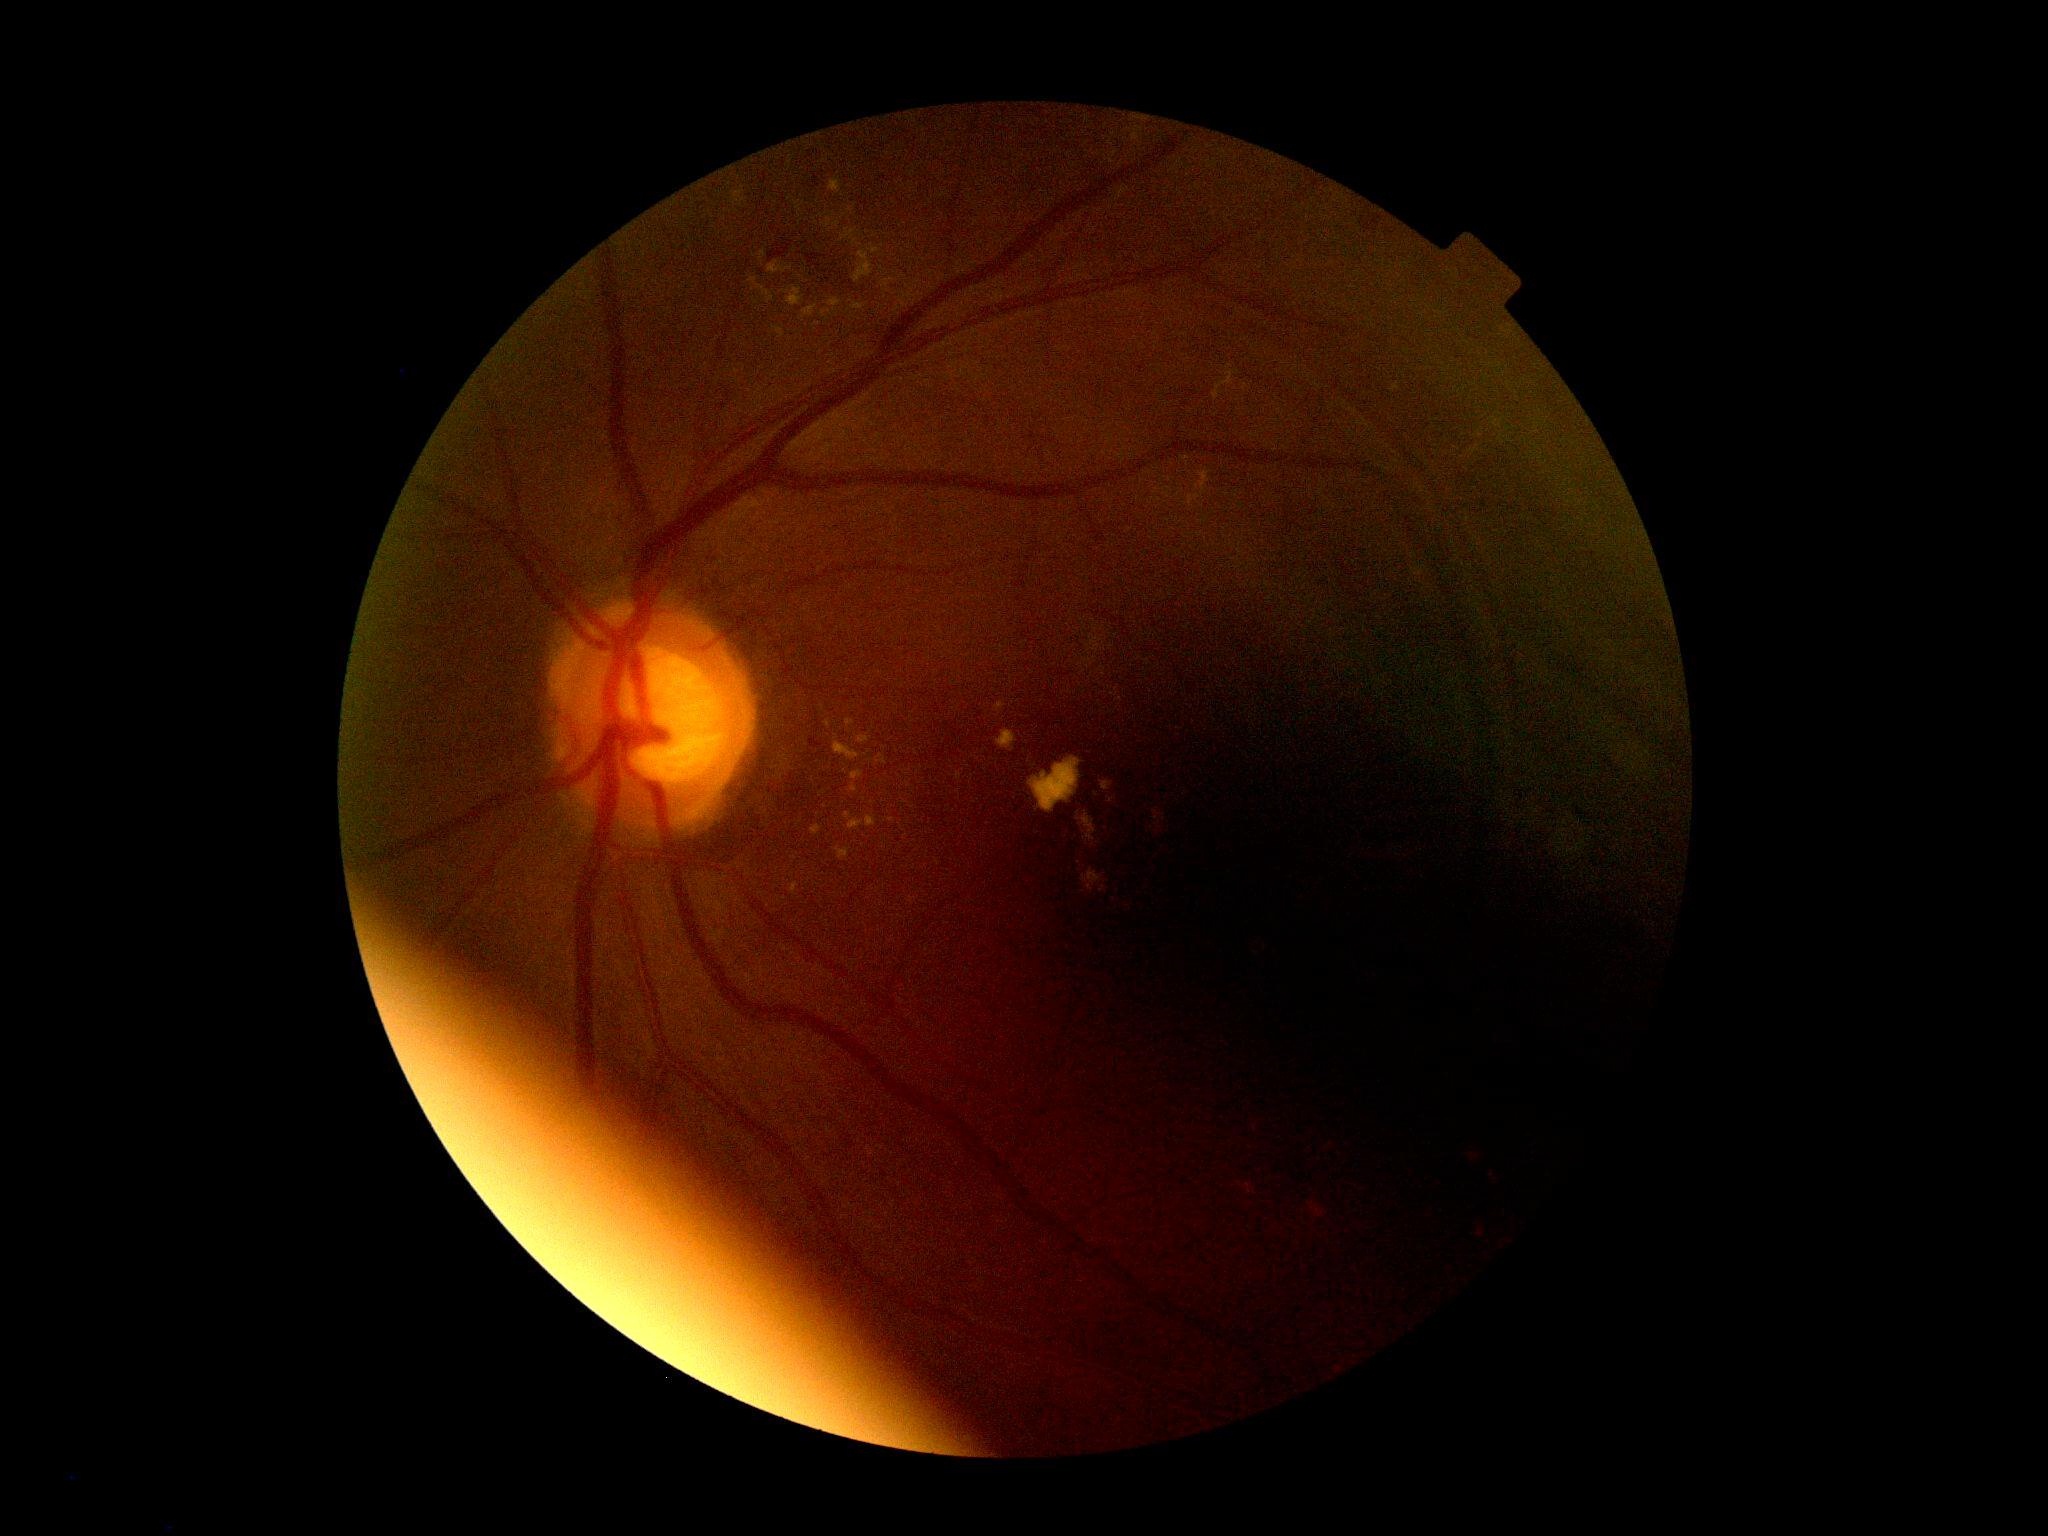

Retinopathy grade: 2.